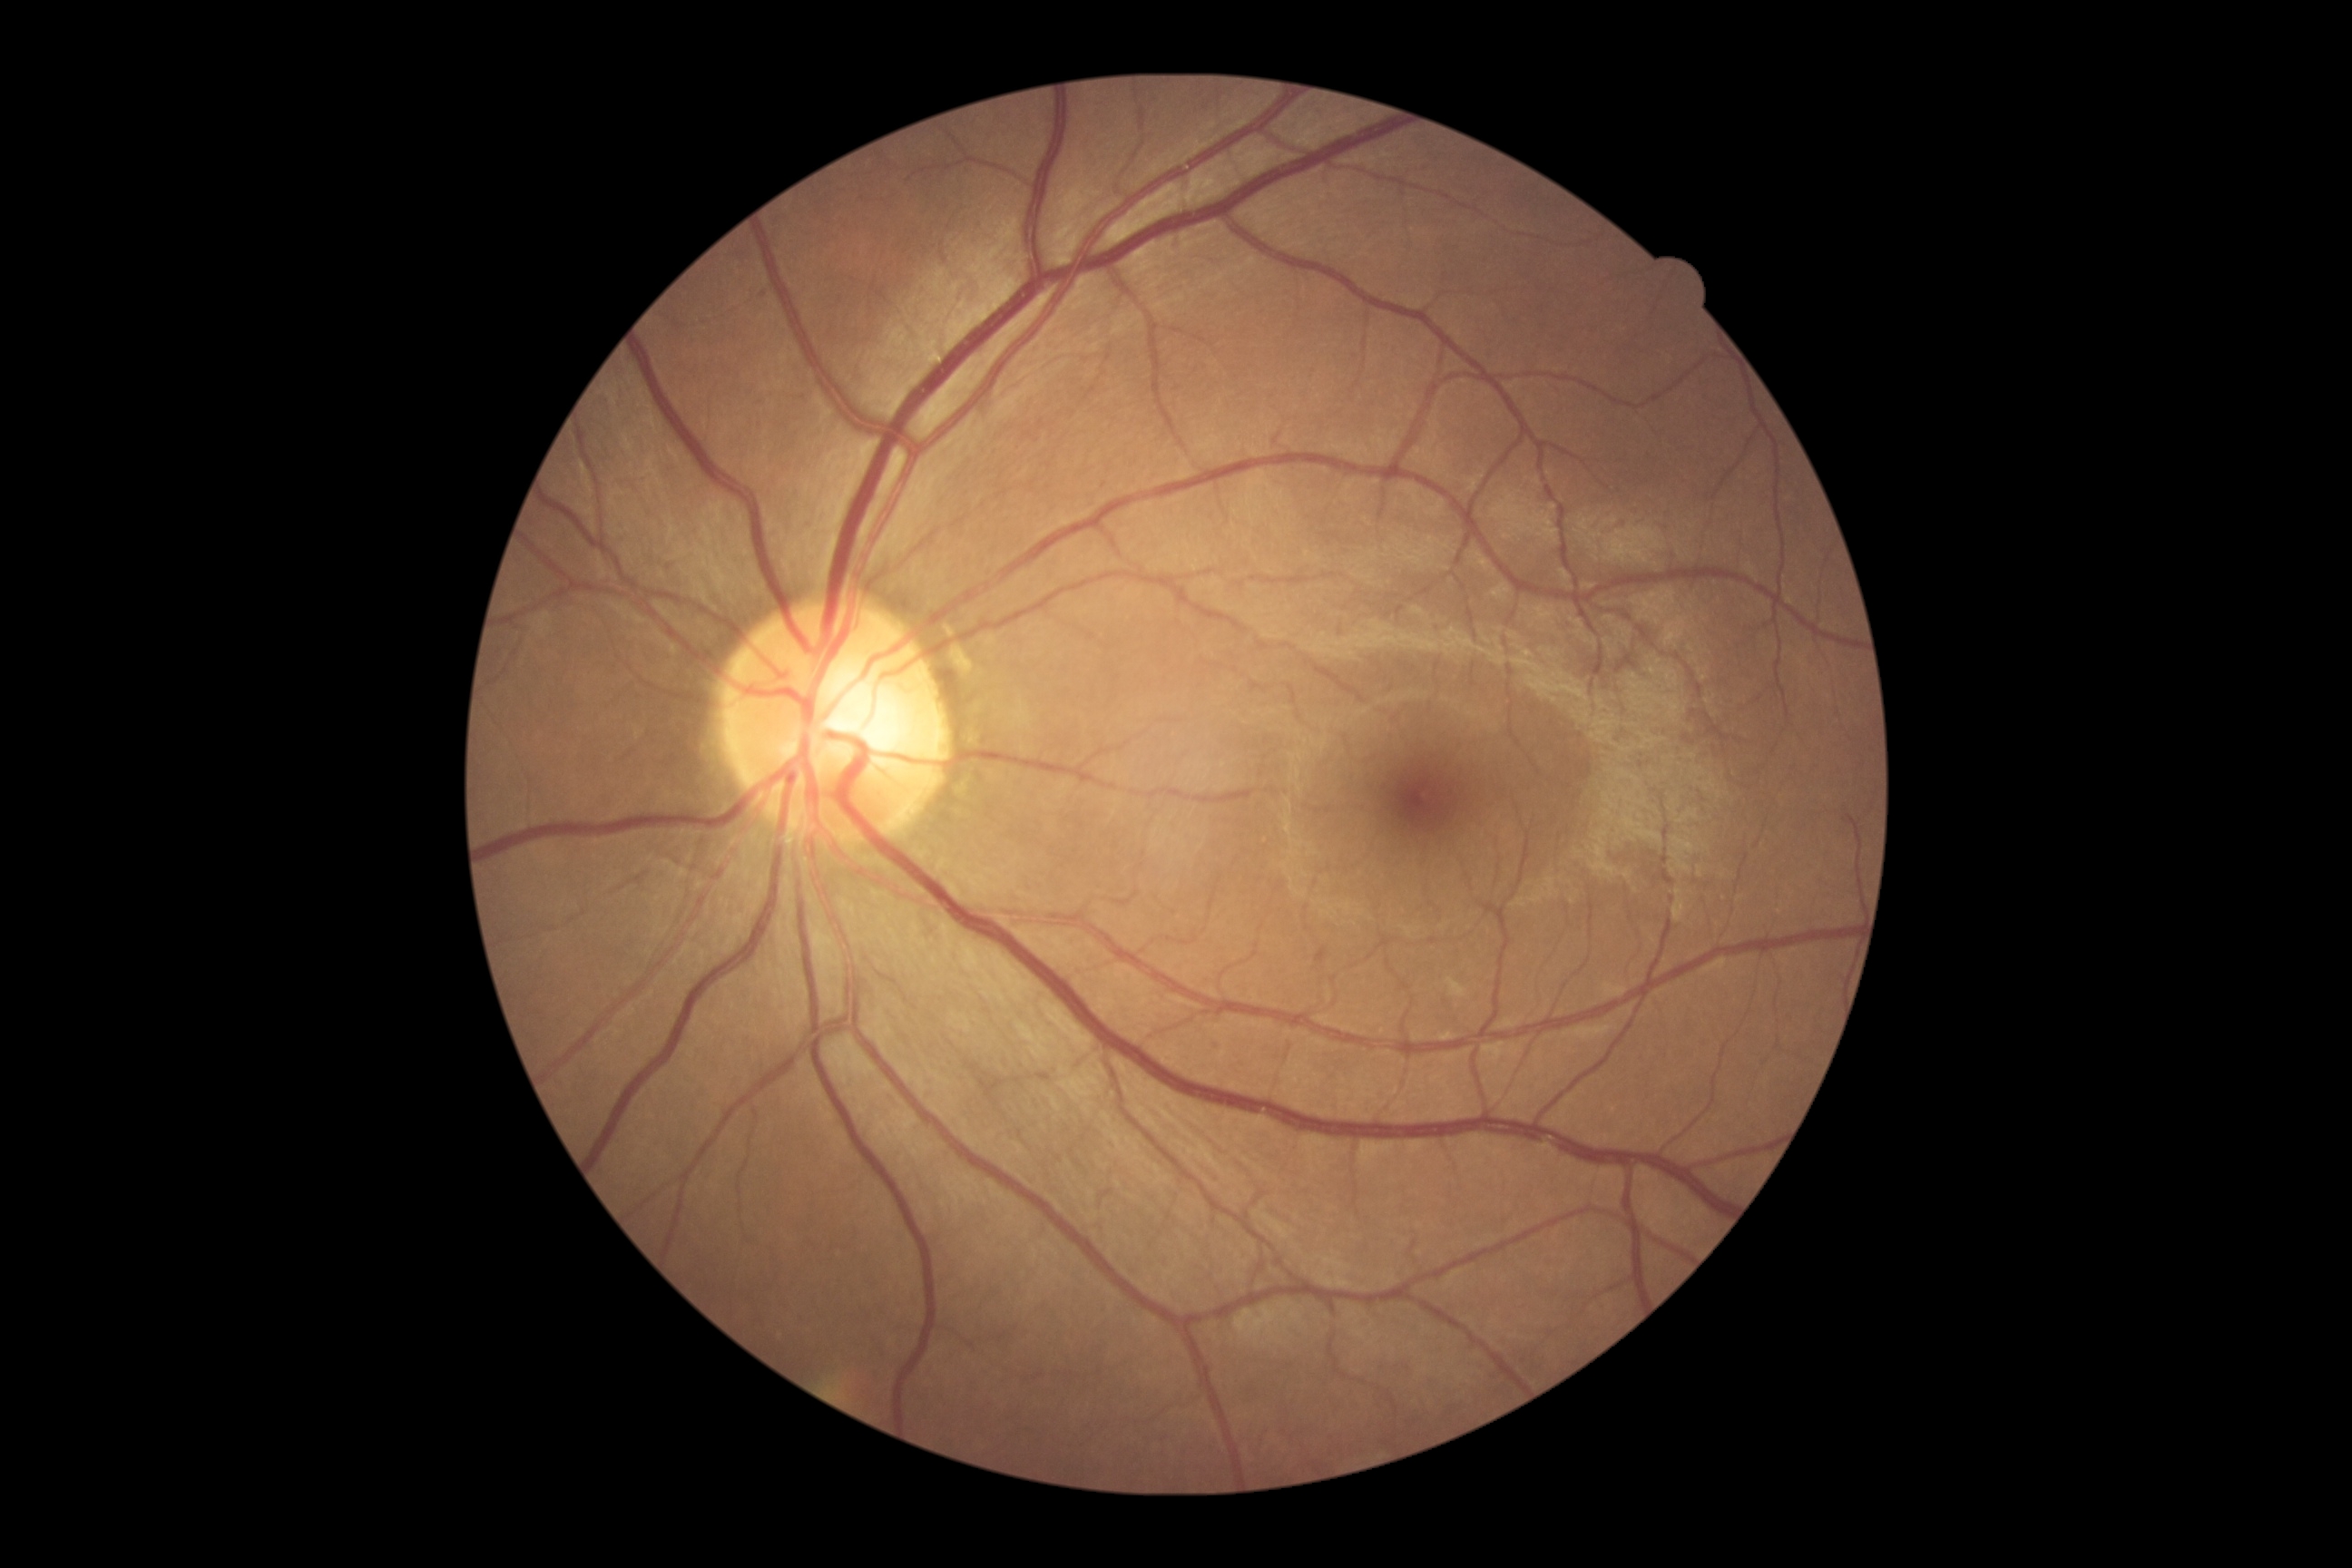

Retinopathy grade: 0.